Color fundus image · 1932x1916px
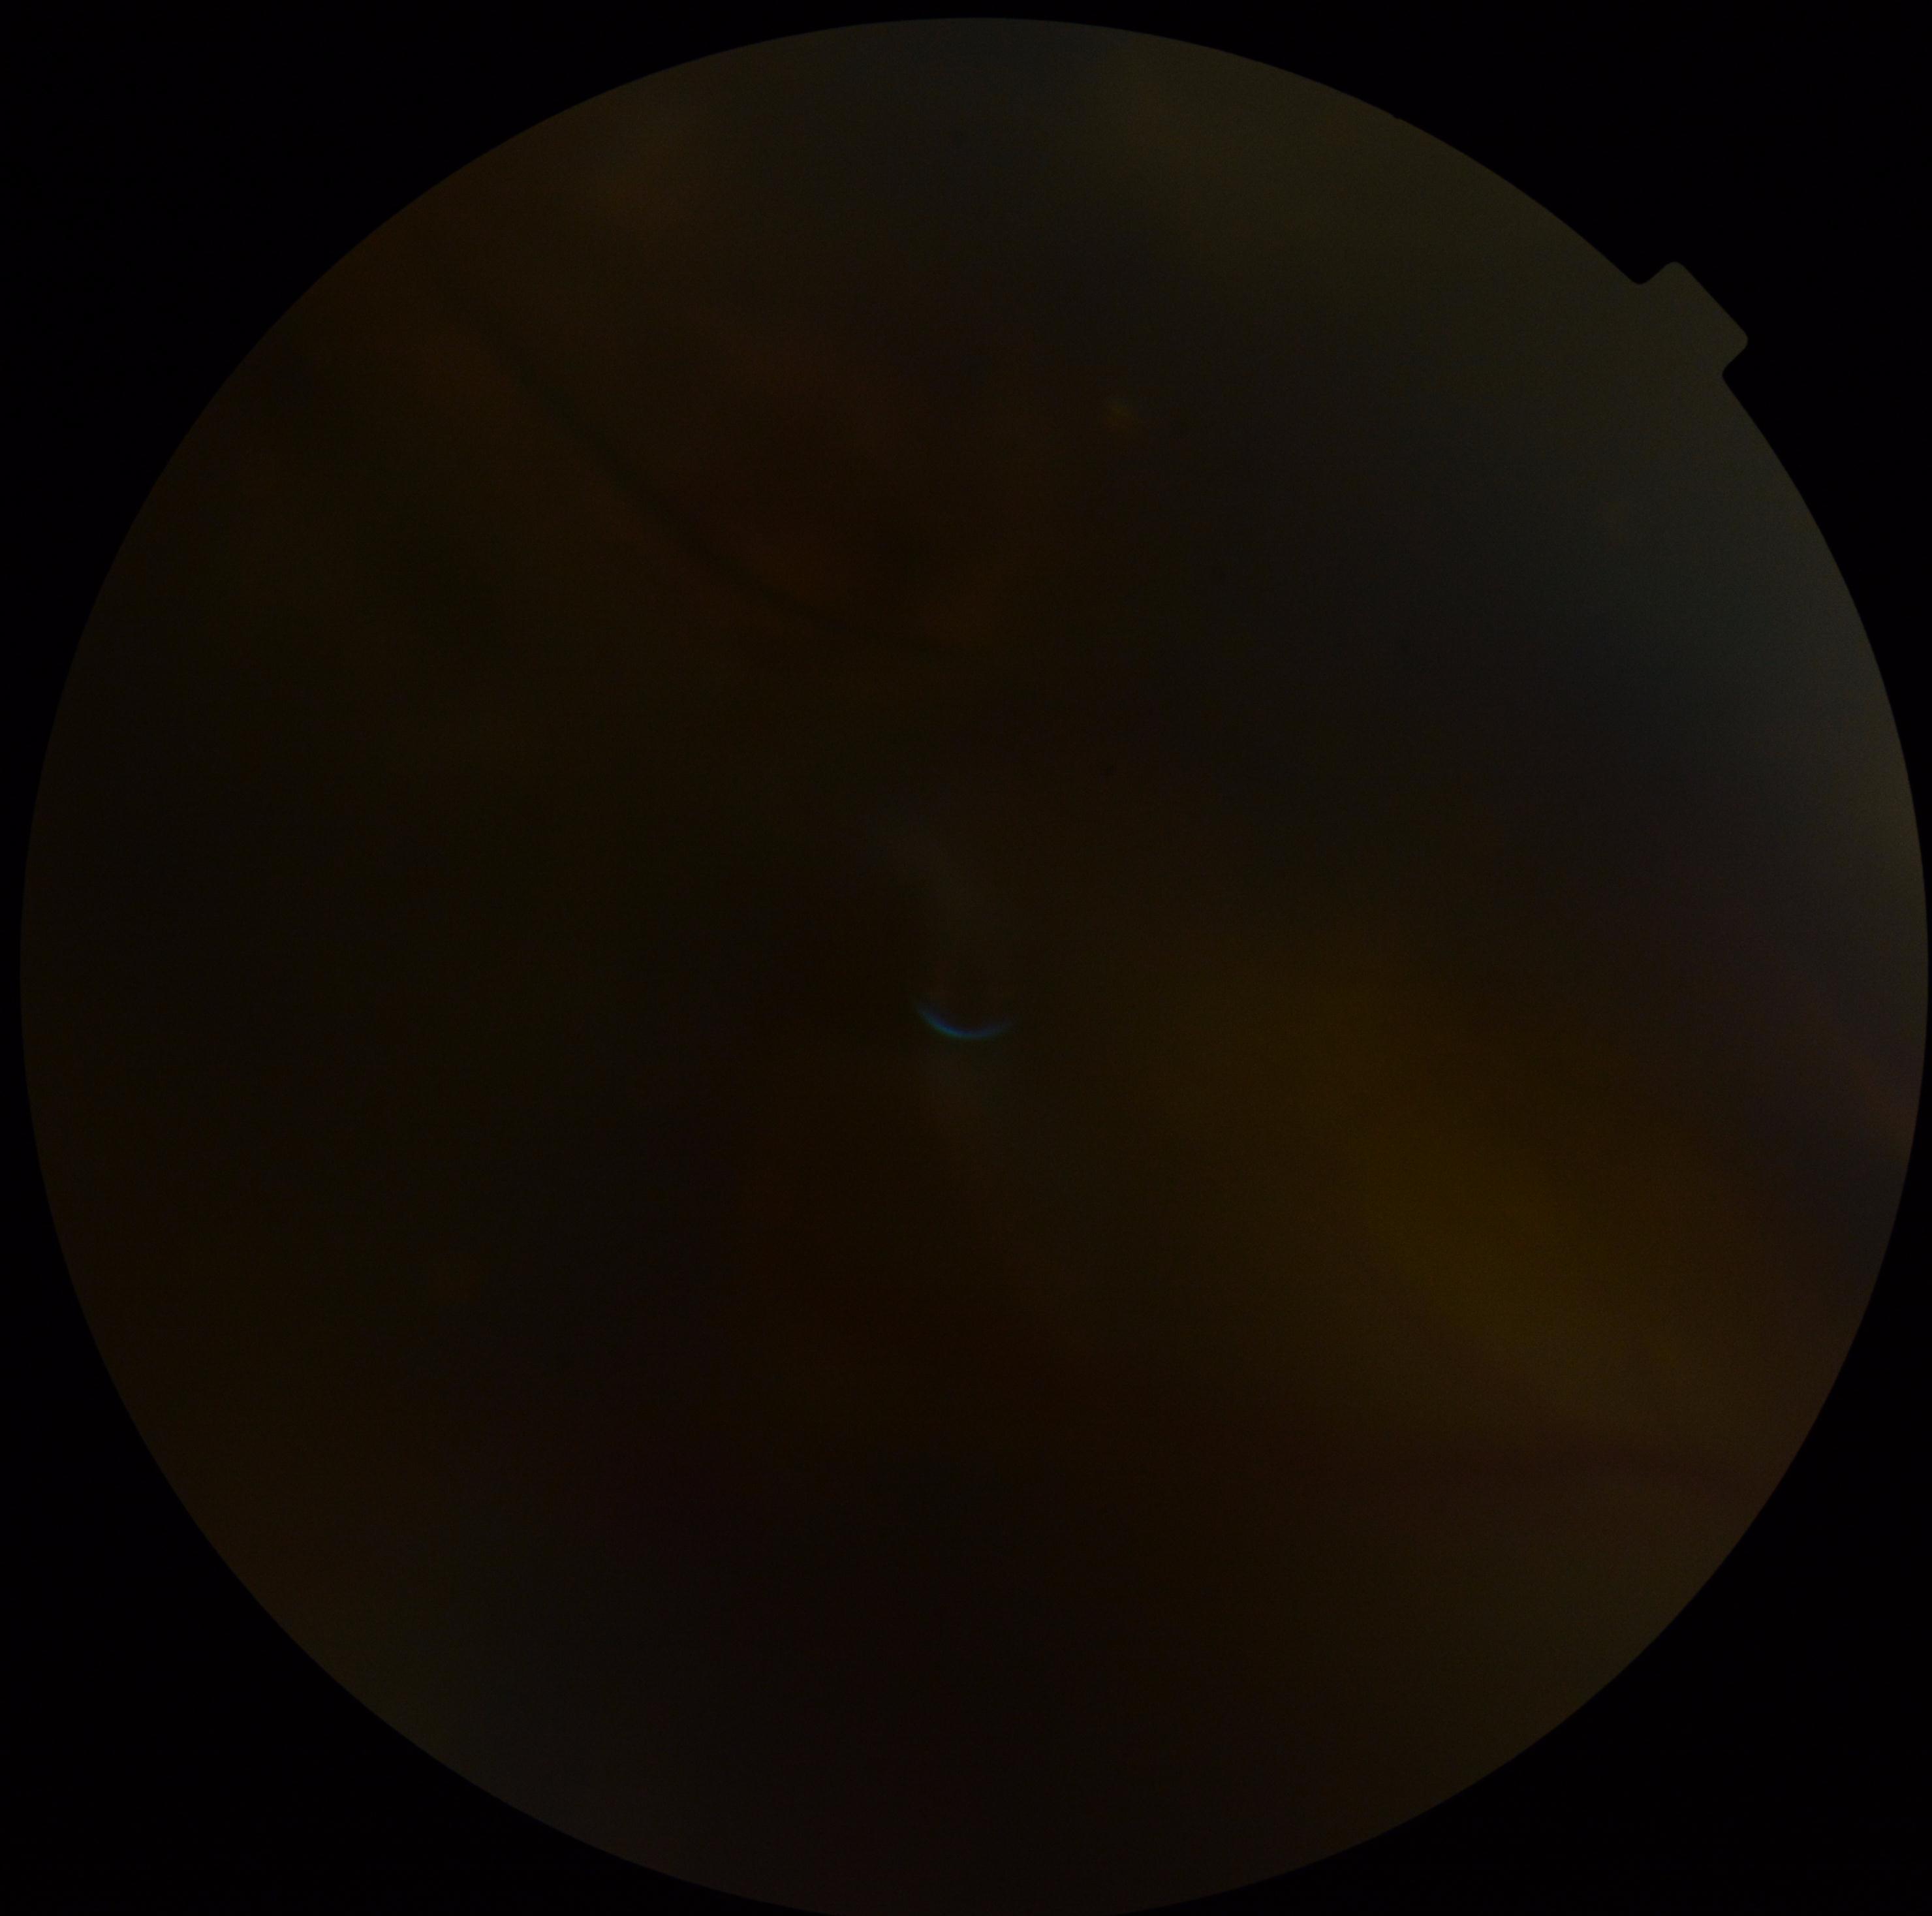 Diabetic retinopathy (DR) is ungradable due to poor image quality.